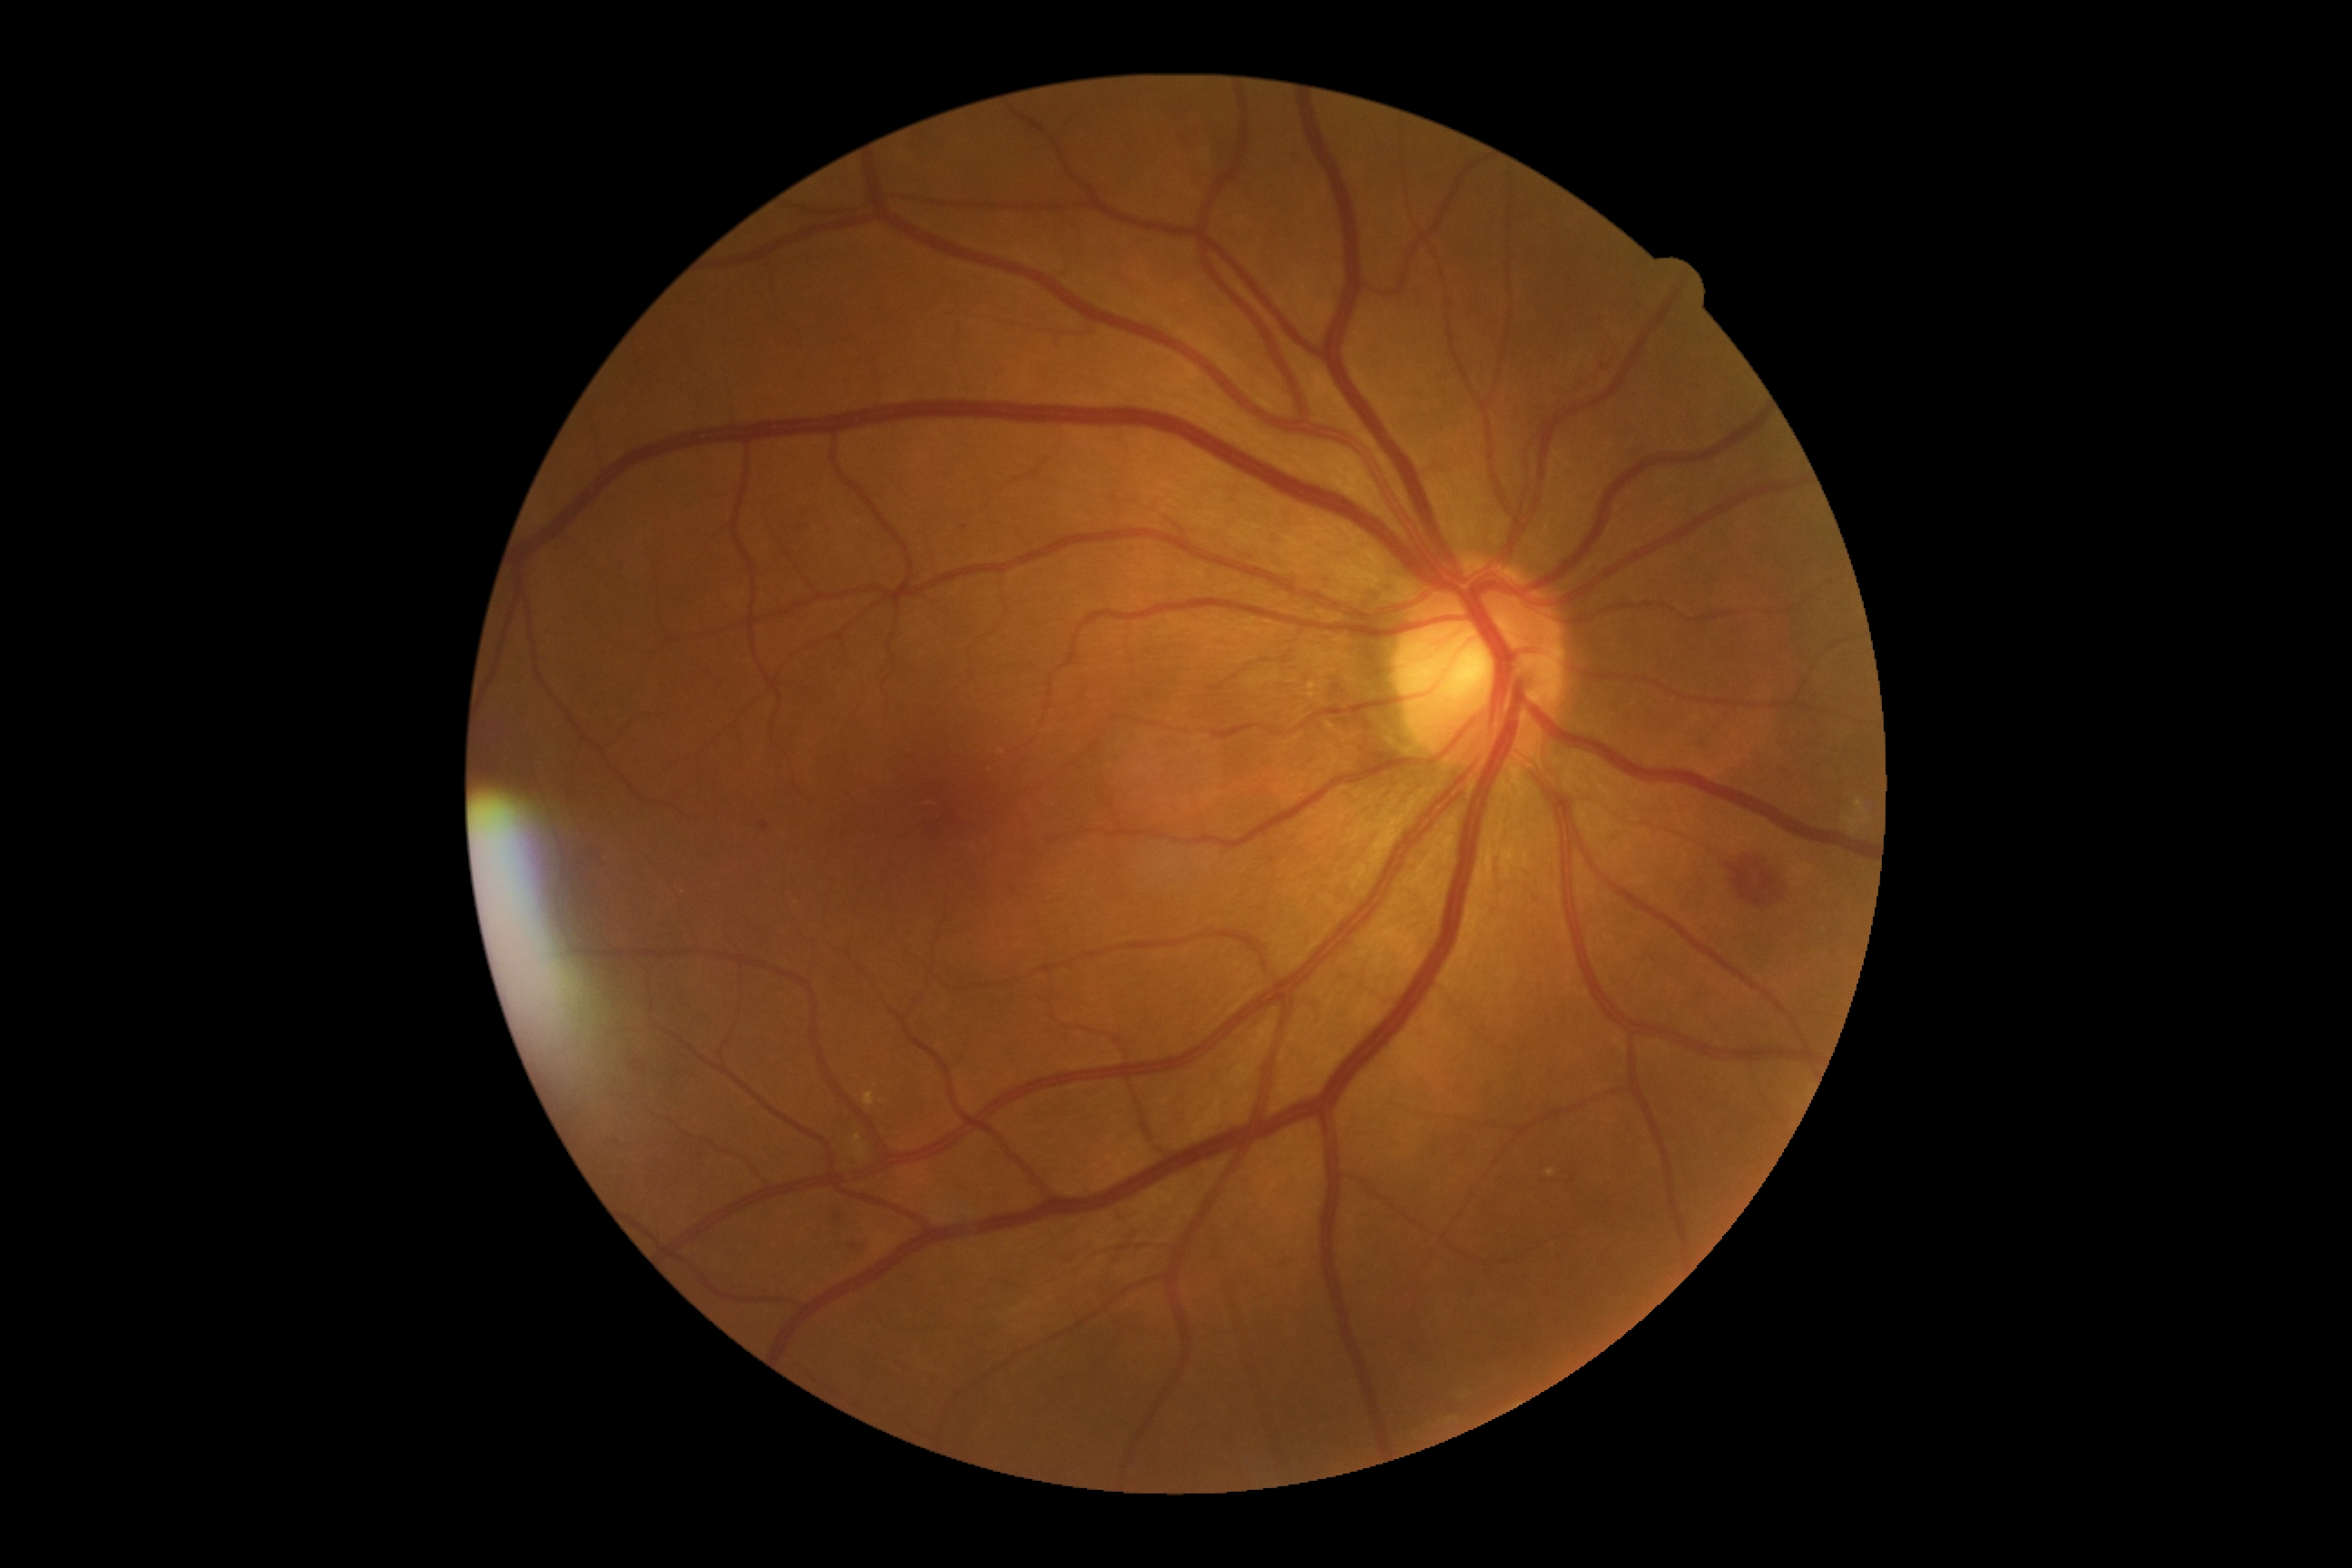
retinopathy = grade 2 (moderate NPDR)